NIDEK AFC-230, image size 848x848, nonmydriatic, modified Davis classification — 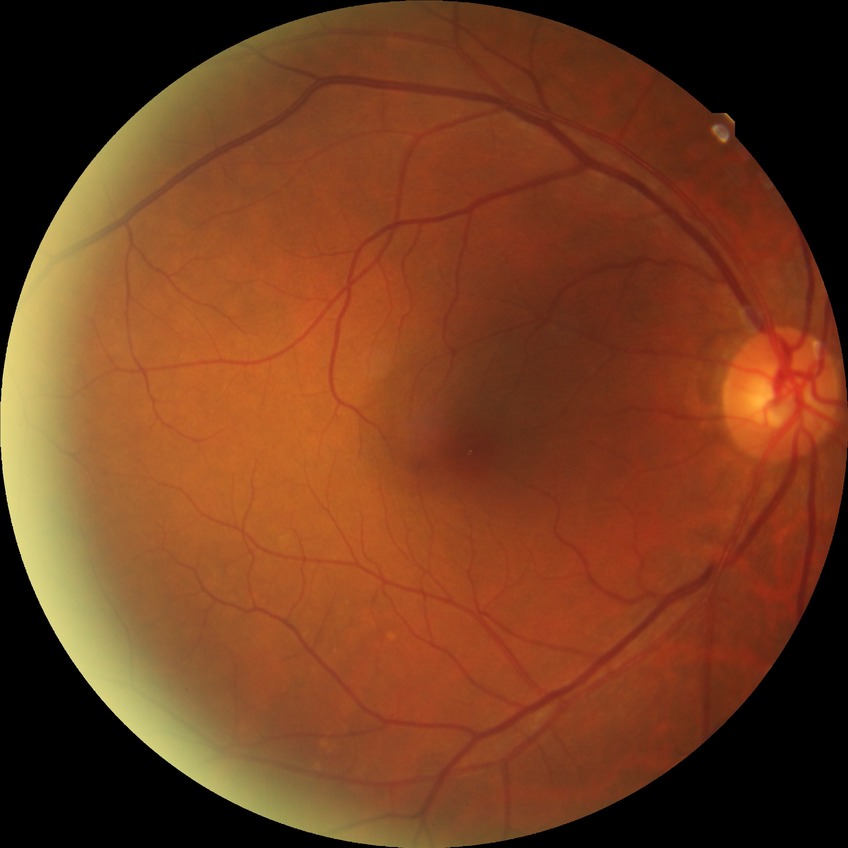

Diabetic retinopathy (DR): no diabetic retinopathy (NDR).